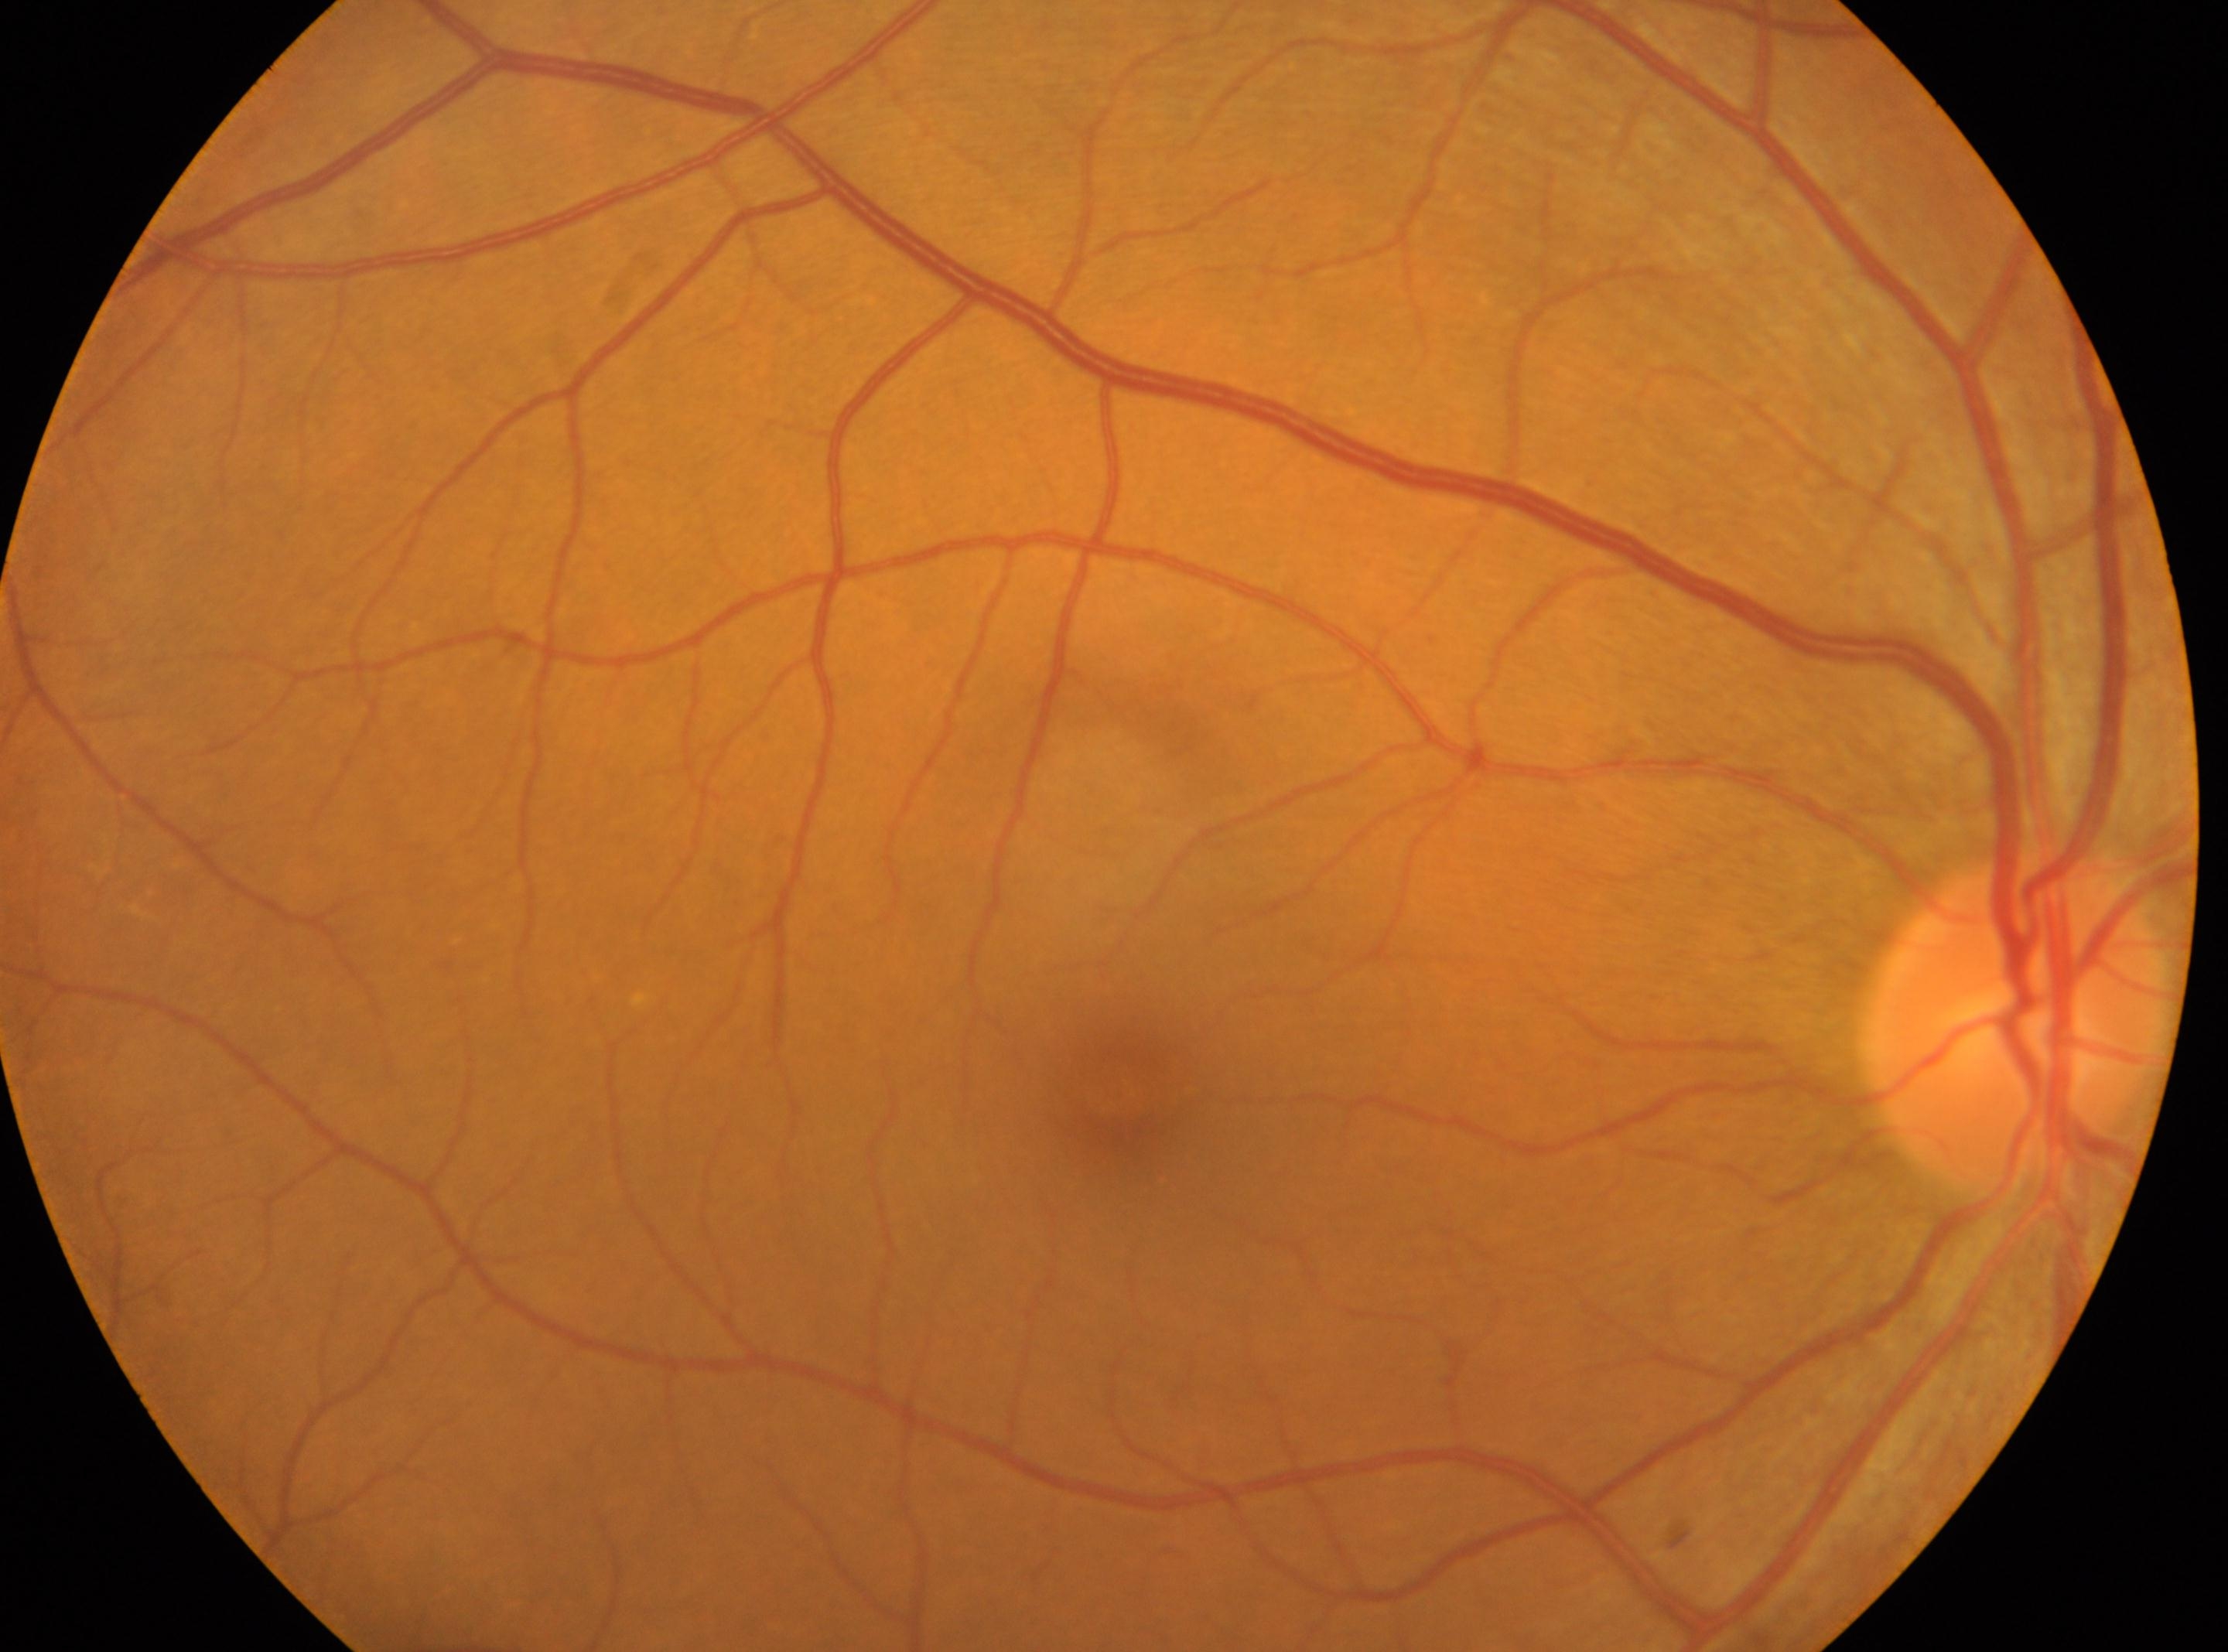

Macular center located at (x=1125, y=1098). Eye: oculus dexter. Optic disc located at (x=2019, y=1020). Retinopathy: 0/4. No diabetic retinopathy identified.